Pediatric wide-field fundus photograph. 640x480px.
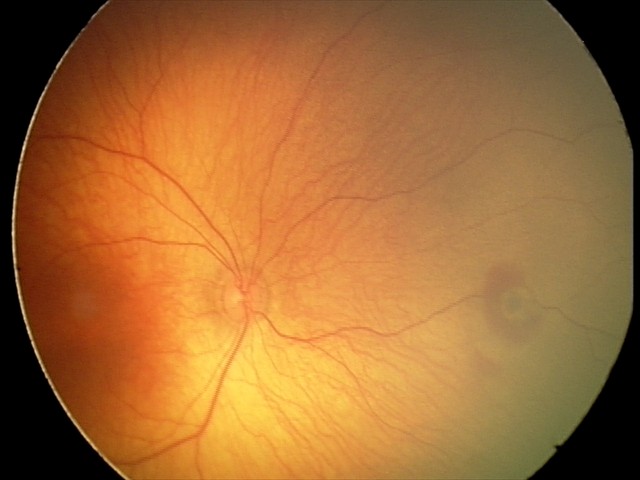
Assessment: retinal hemorrhages.